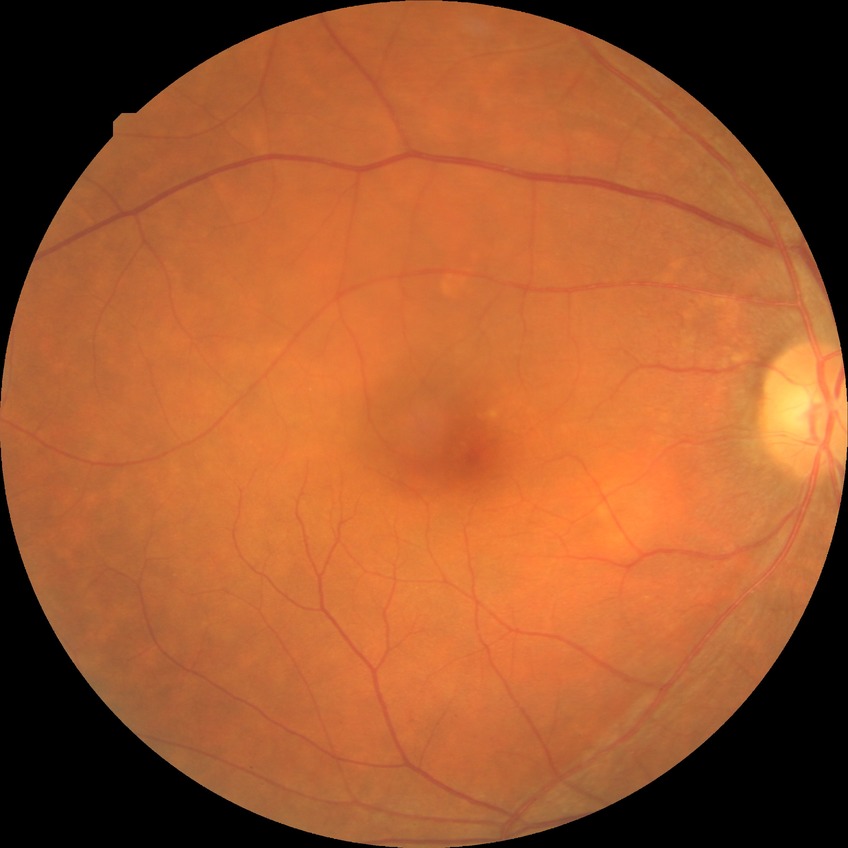 Diabetic retinopathy (DR) is NDR (no diabetic retinopathy).